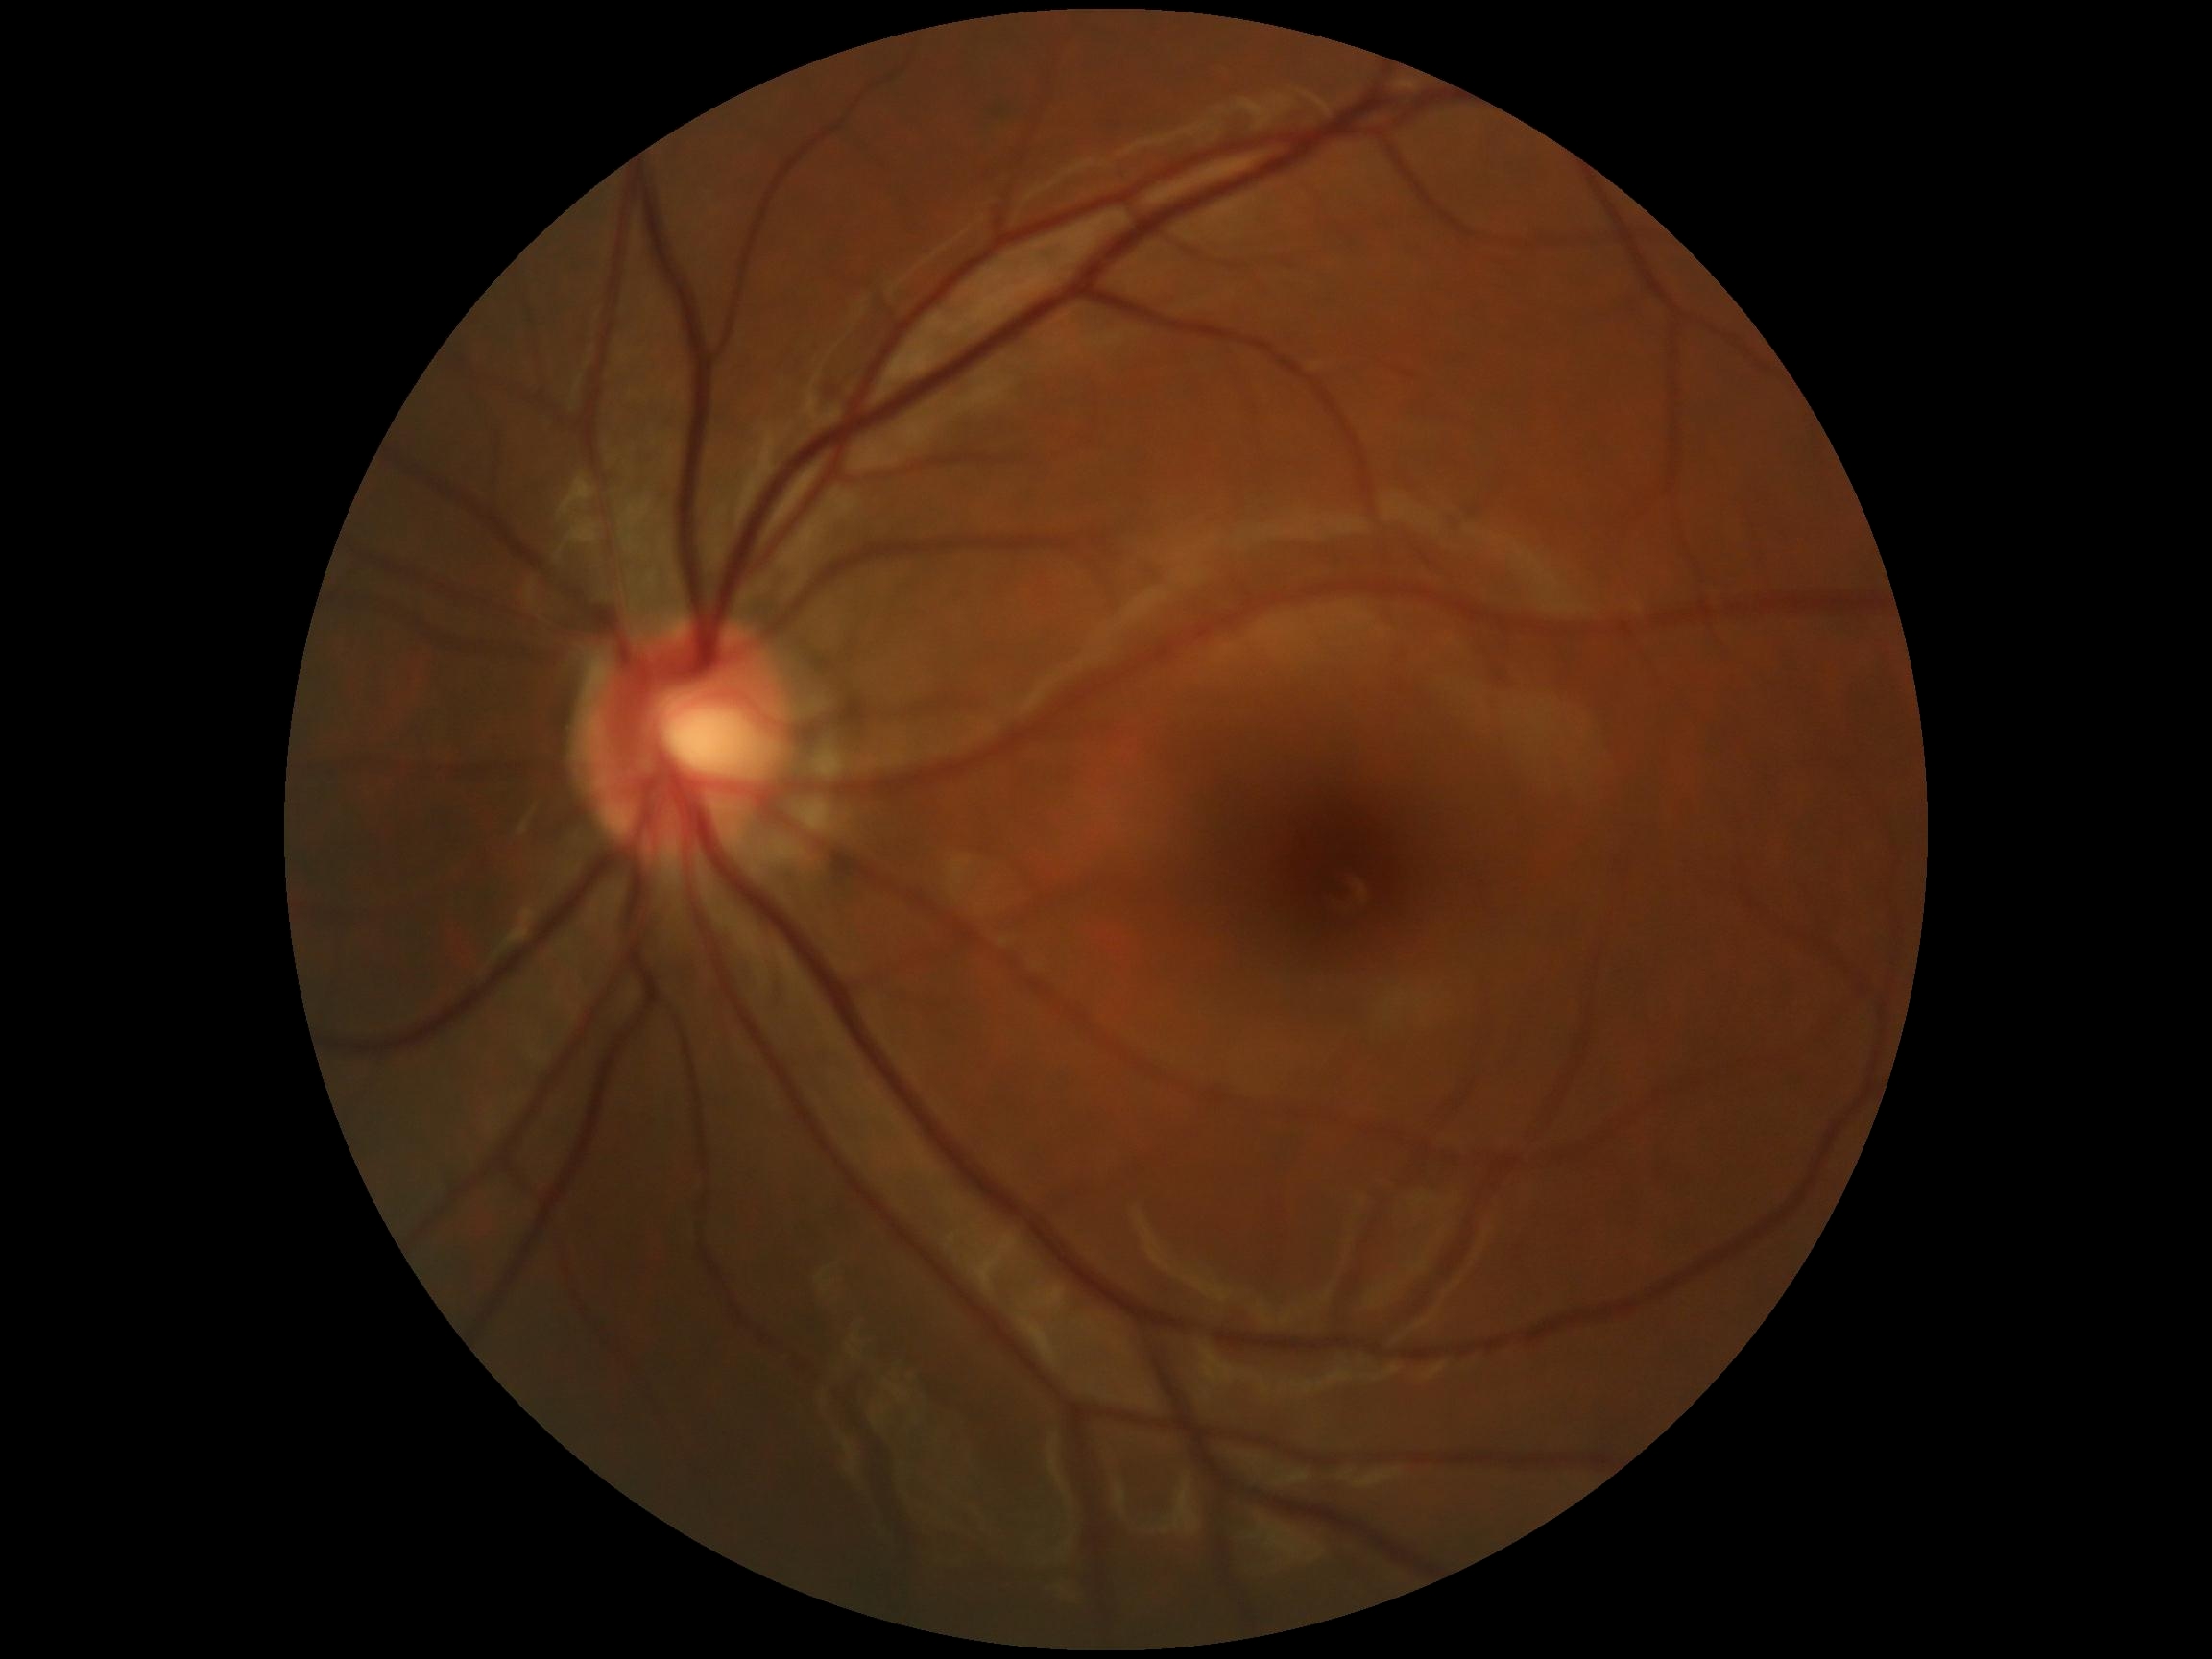   dr_grade: grade 0 (no apparent retinopathy)